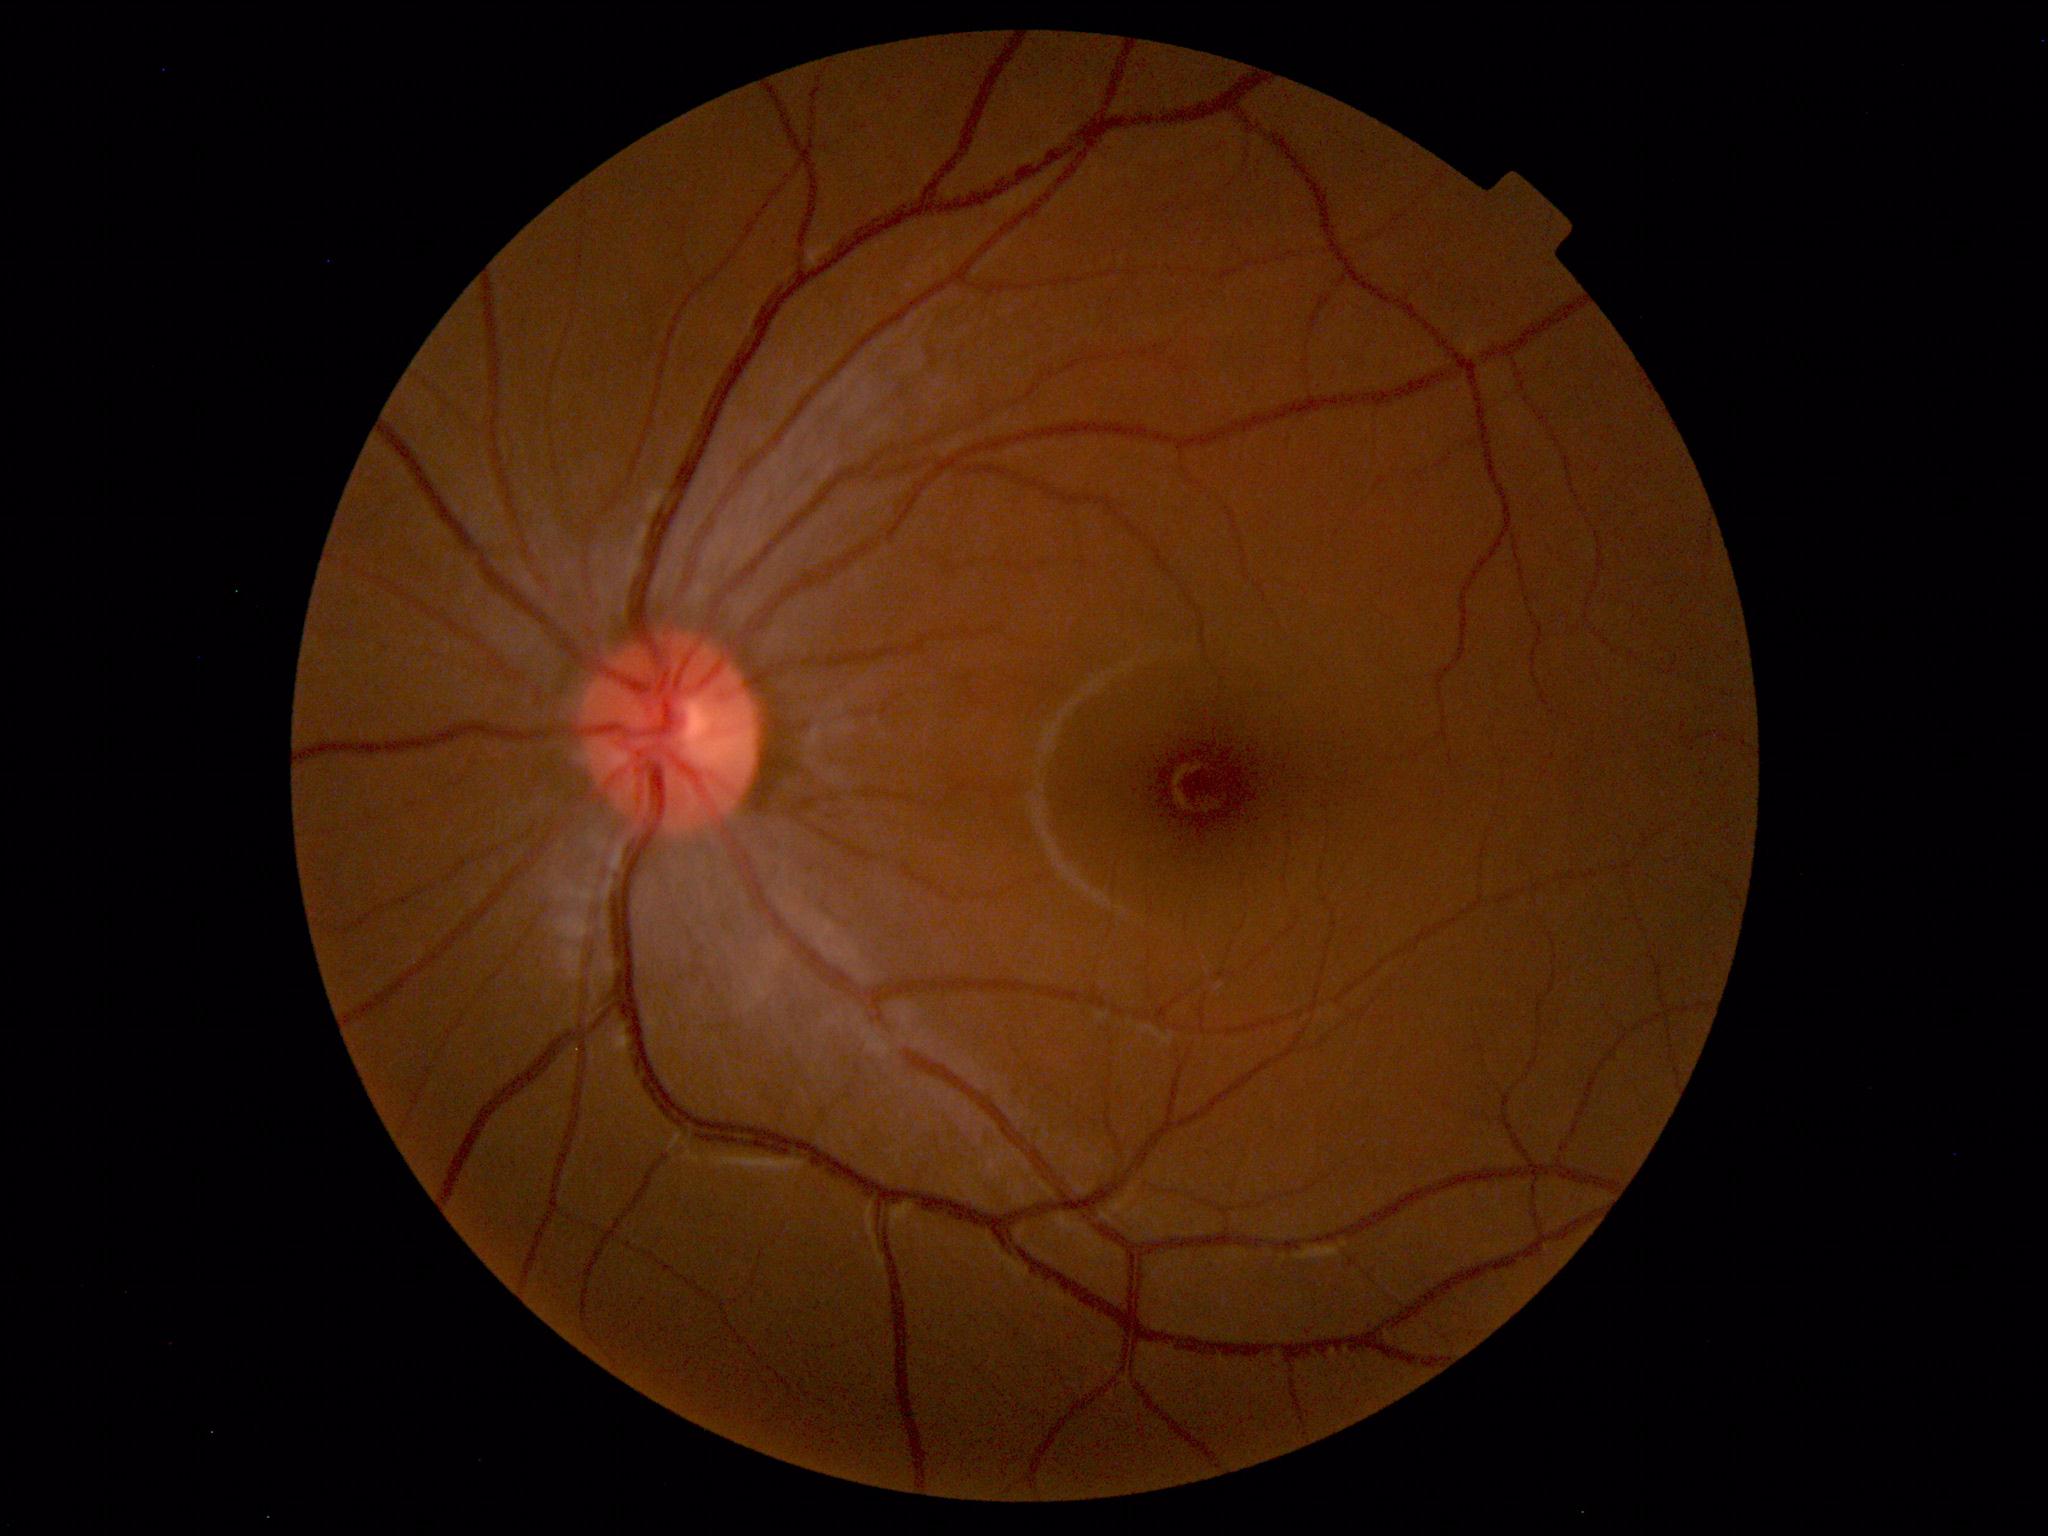 No retinal pathology identified.